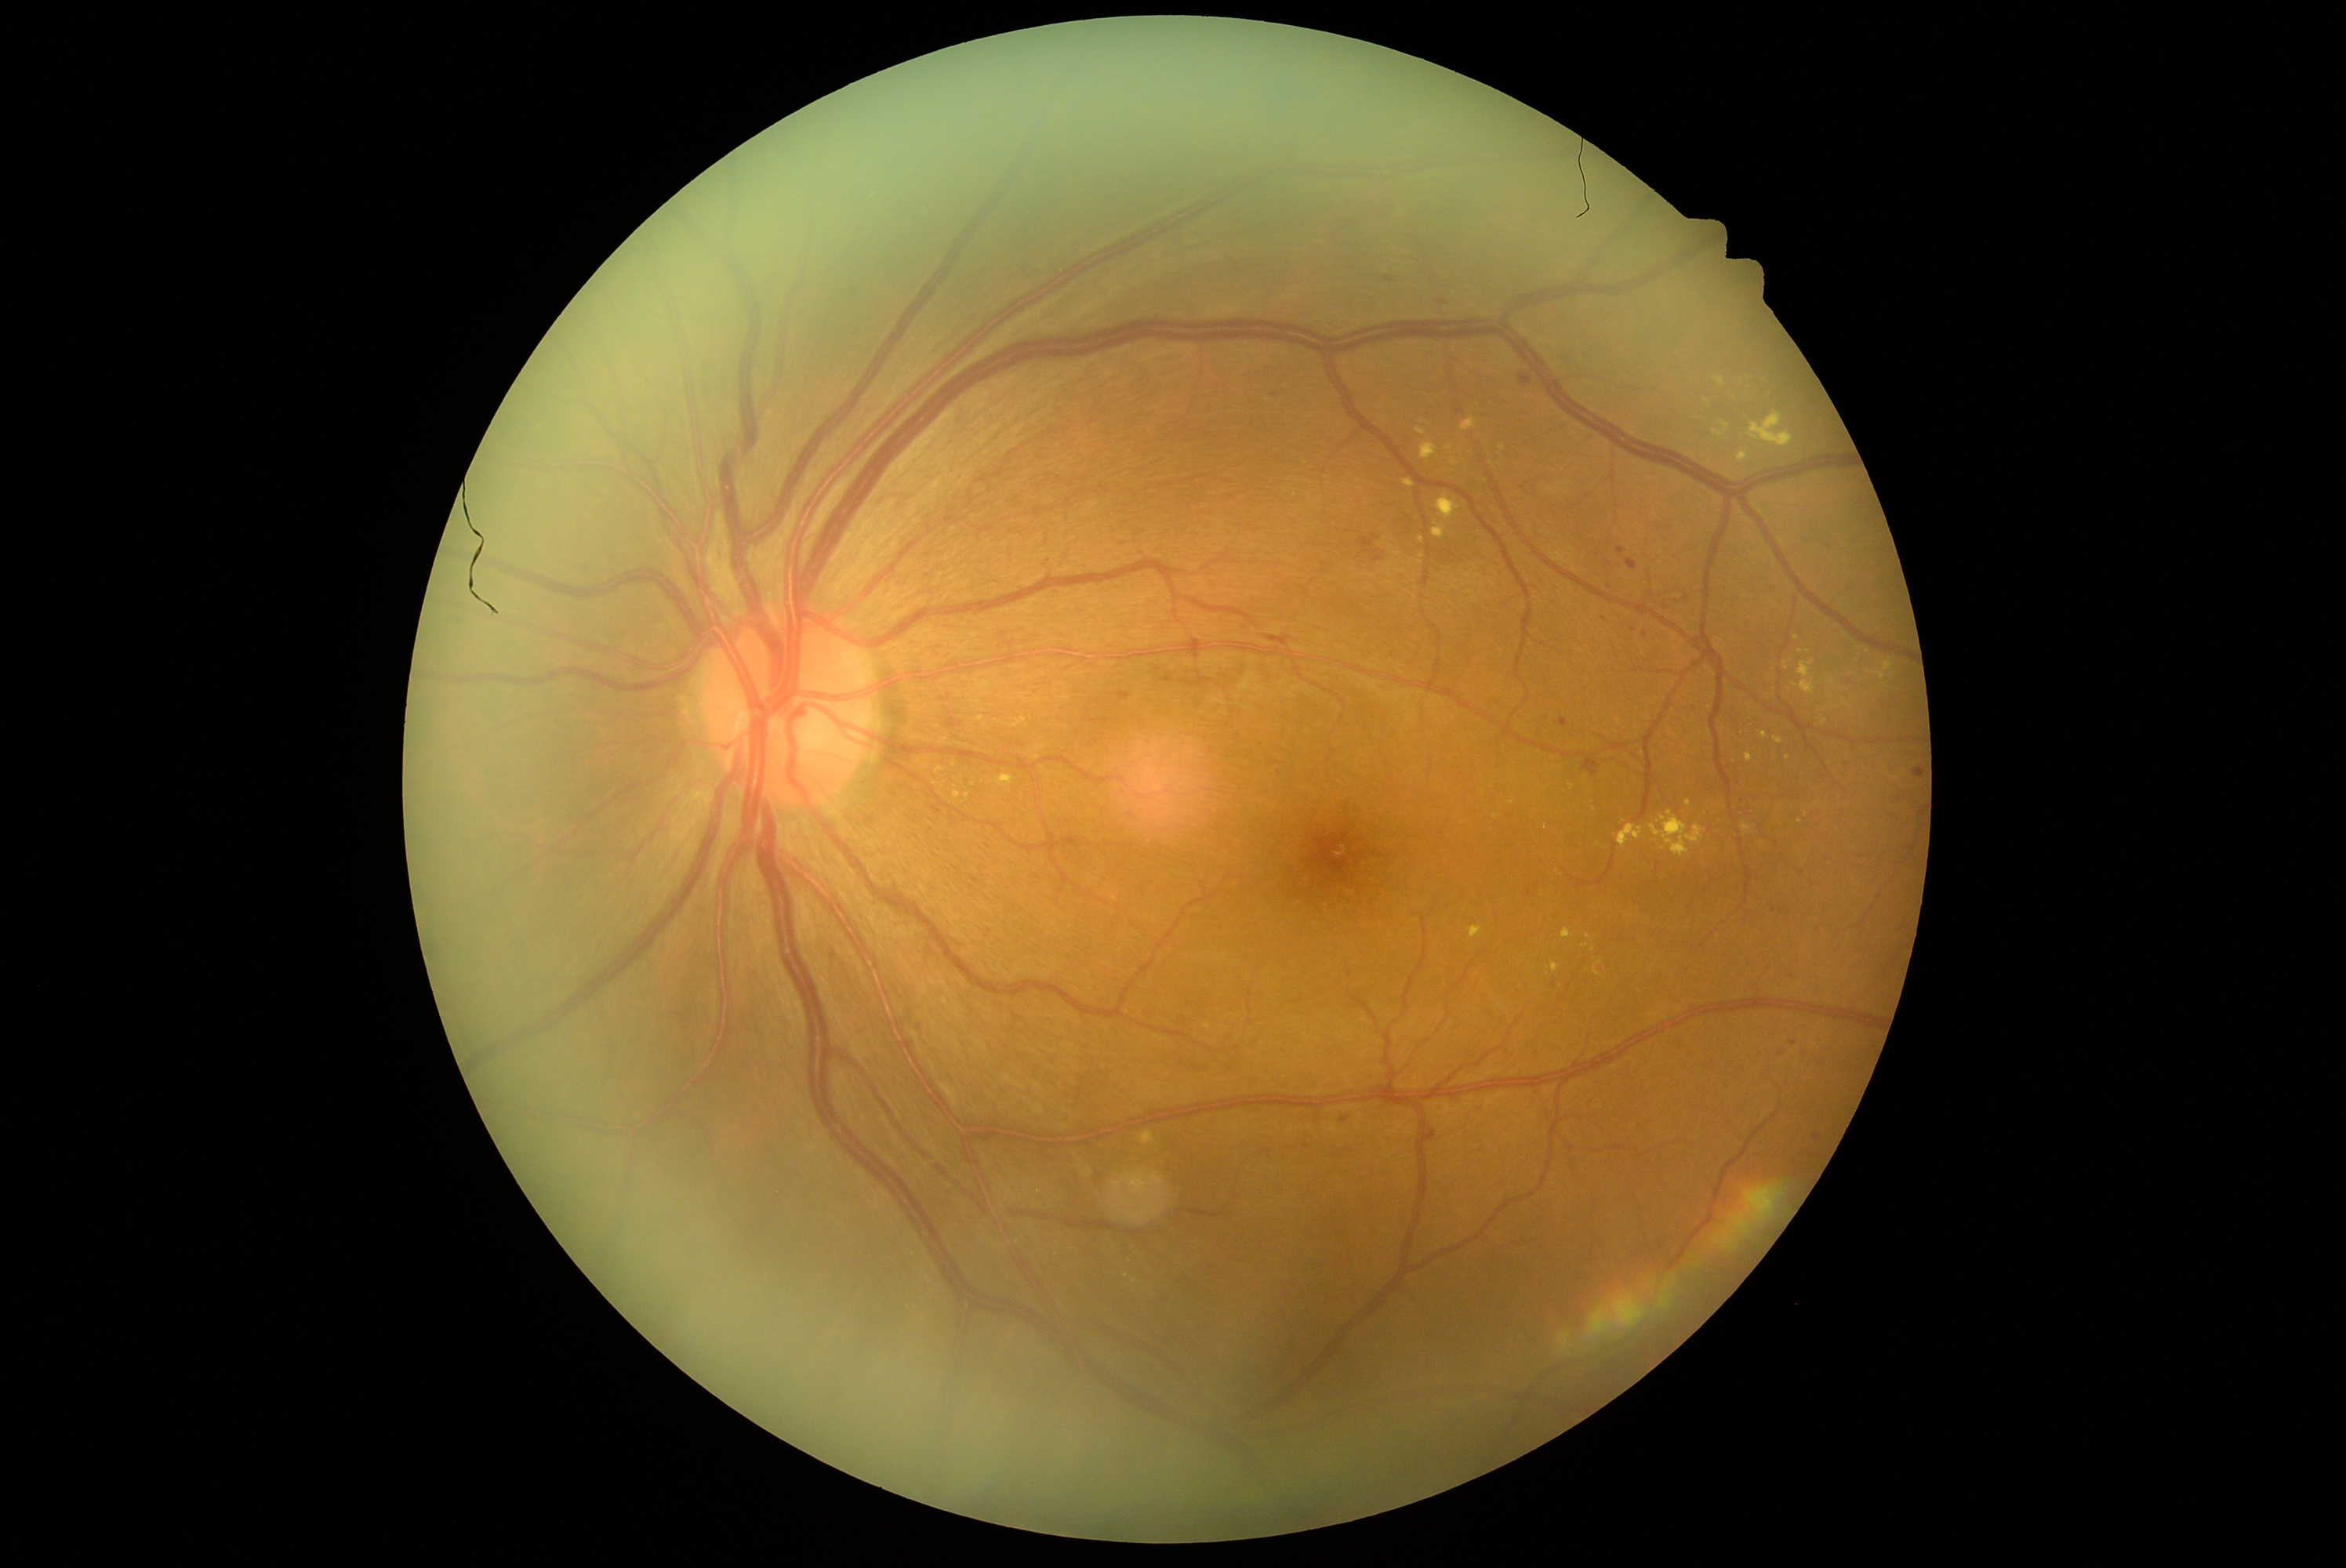 {"partial": true, "dr_grade": 2, "dr_grade_name": "moderate NPDR", "lesions": {"he": [[1789, 975, 1796, 984], [1773, 909, 1784, 913], [824, 946, 843, 965], [1690, 702, 1698, 713], [1113, 686, 1133, 702], [1520, 374, 1531, 388], [1125, 811, 1136, 821], [1428, 1130, 1436, 1142]], "he_small_centers": [[1817, 1138], [1899, 798], [1666, 607], [1829, 546], [1276, 395], [1770, 731], [1633, 630], [1610, 564], [1536, 886]], "ex": [[1436, 495, 1459, 520], [1785, 662, 1789, 670], [1415, 427, 1428, 437], [1141, 1133, 1155, 1144], [1749, 410, 1795, 449], [973, 714, 982, 722], [1498, 446, 1506, 452], [1469, 926, 1484, 940], [1774, 738, 1784, 746], [1721, 421, 1730, 432]], "ex_small_centers": [[1511, 803], [1588, 937], [1126, 1276], [1450, 448], [1594, 951], [1830, 695]]}}